Captured on a Nidek AFC-330 fundus camera — 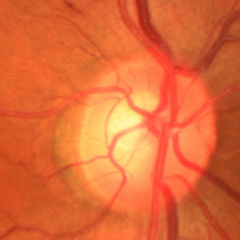 Glaucomatous changes are present. Glaucoma assessment = early-stage glaucoma.